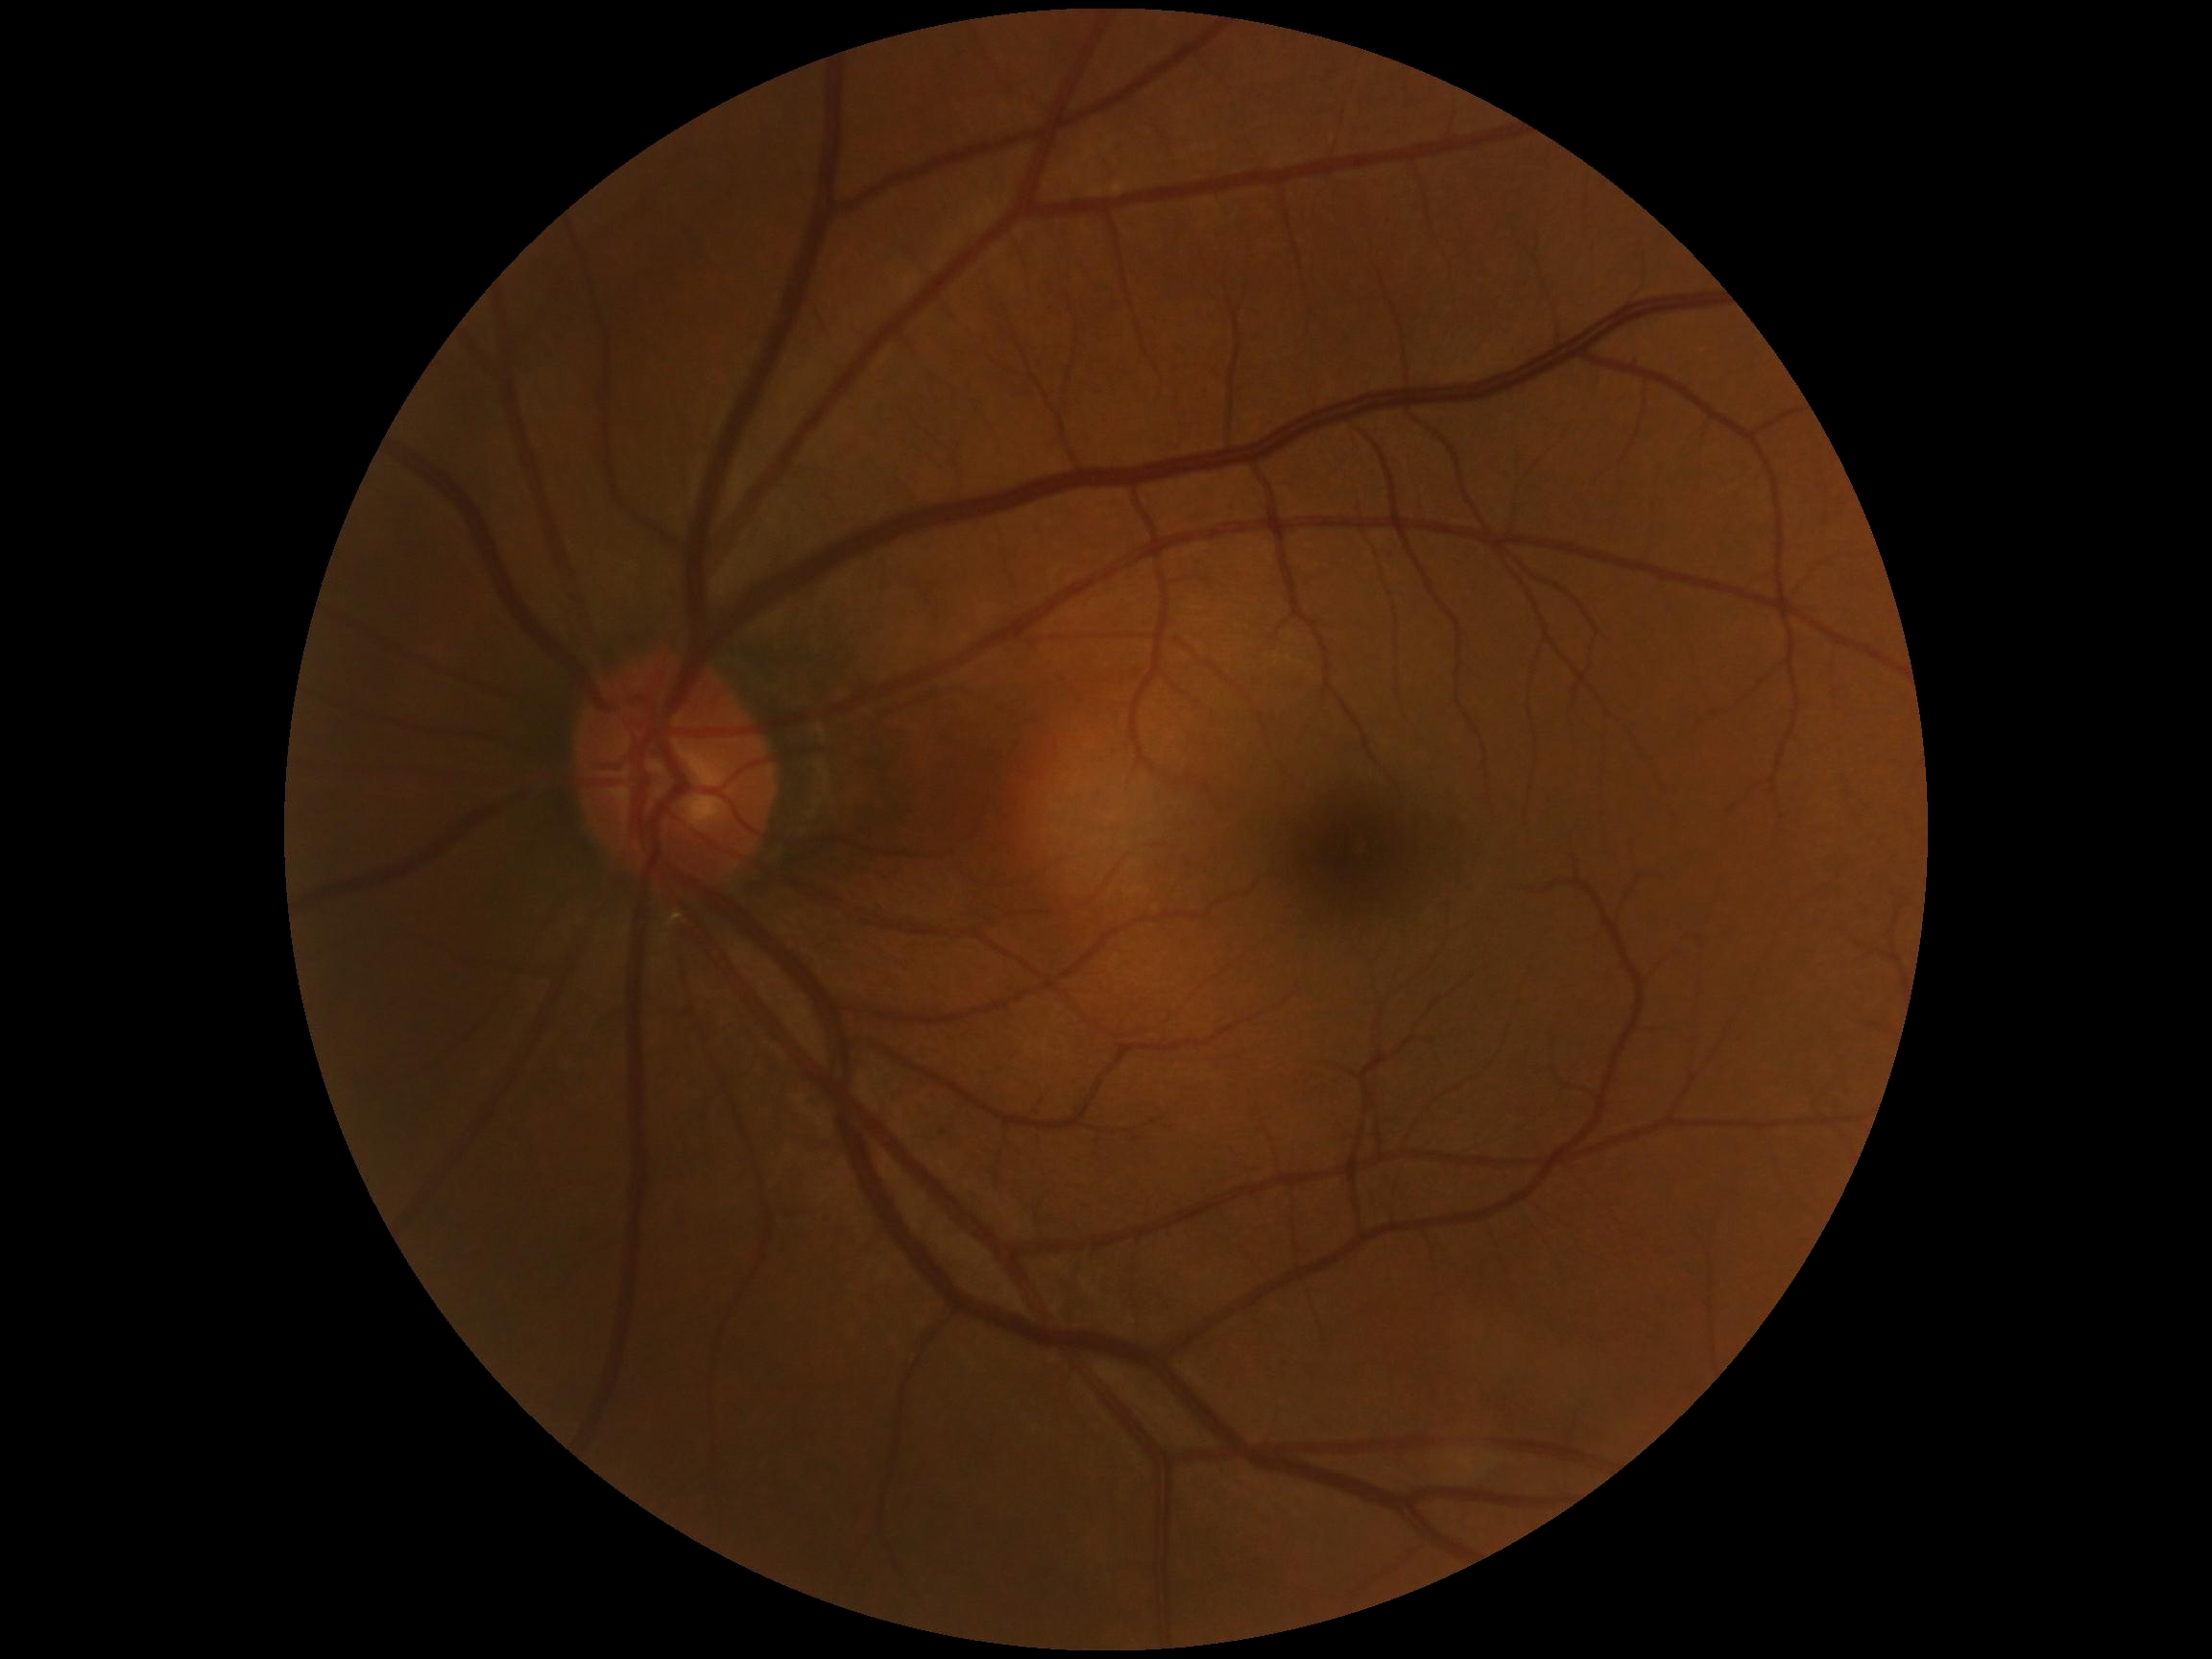 dr_grade: no apparent retinopathy (grade 0) — no visible signs of diabetic retinopathy
dr_impression: negative for DR